640 x 480 pixels; infant wide-field fundus photograph; acquired on the Clarity RetCam 3.
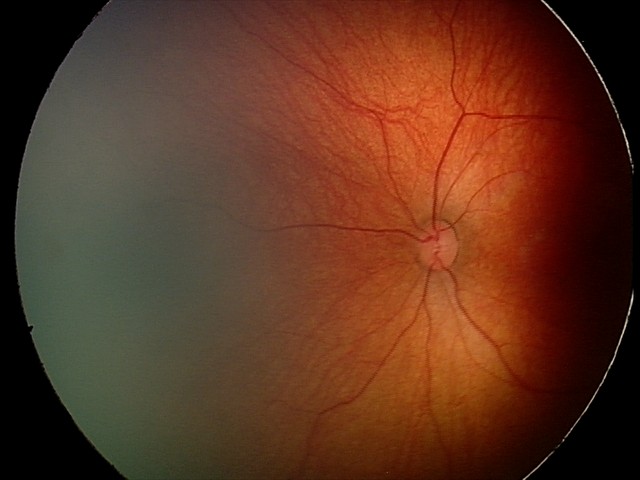 Screening series with retinal hemorrhages.